640x480. Wide-field fundus photograph of an infant. Acquired on the Clarity RetCam 3 — 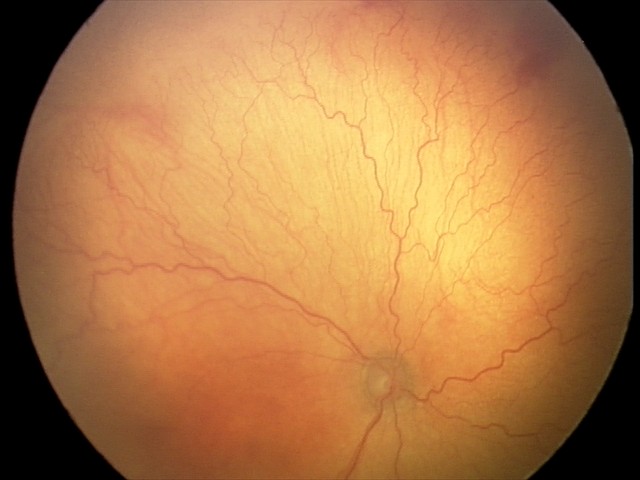 Screening series with aggressive retinopathy of prematurity.
Plus disease present.